Color fundus photograph.
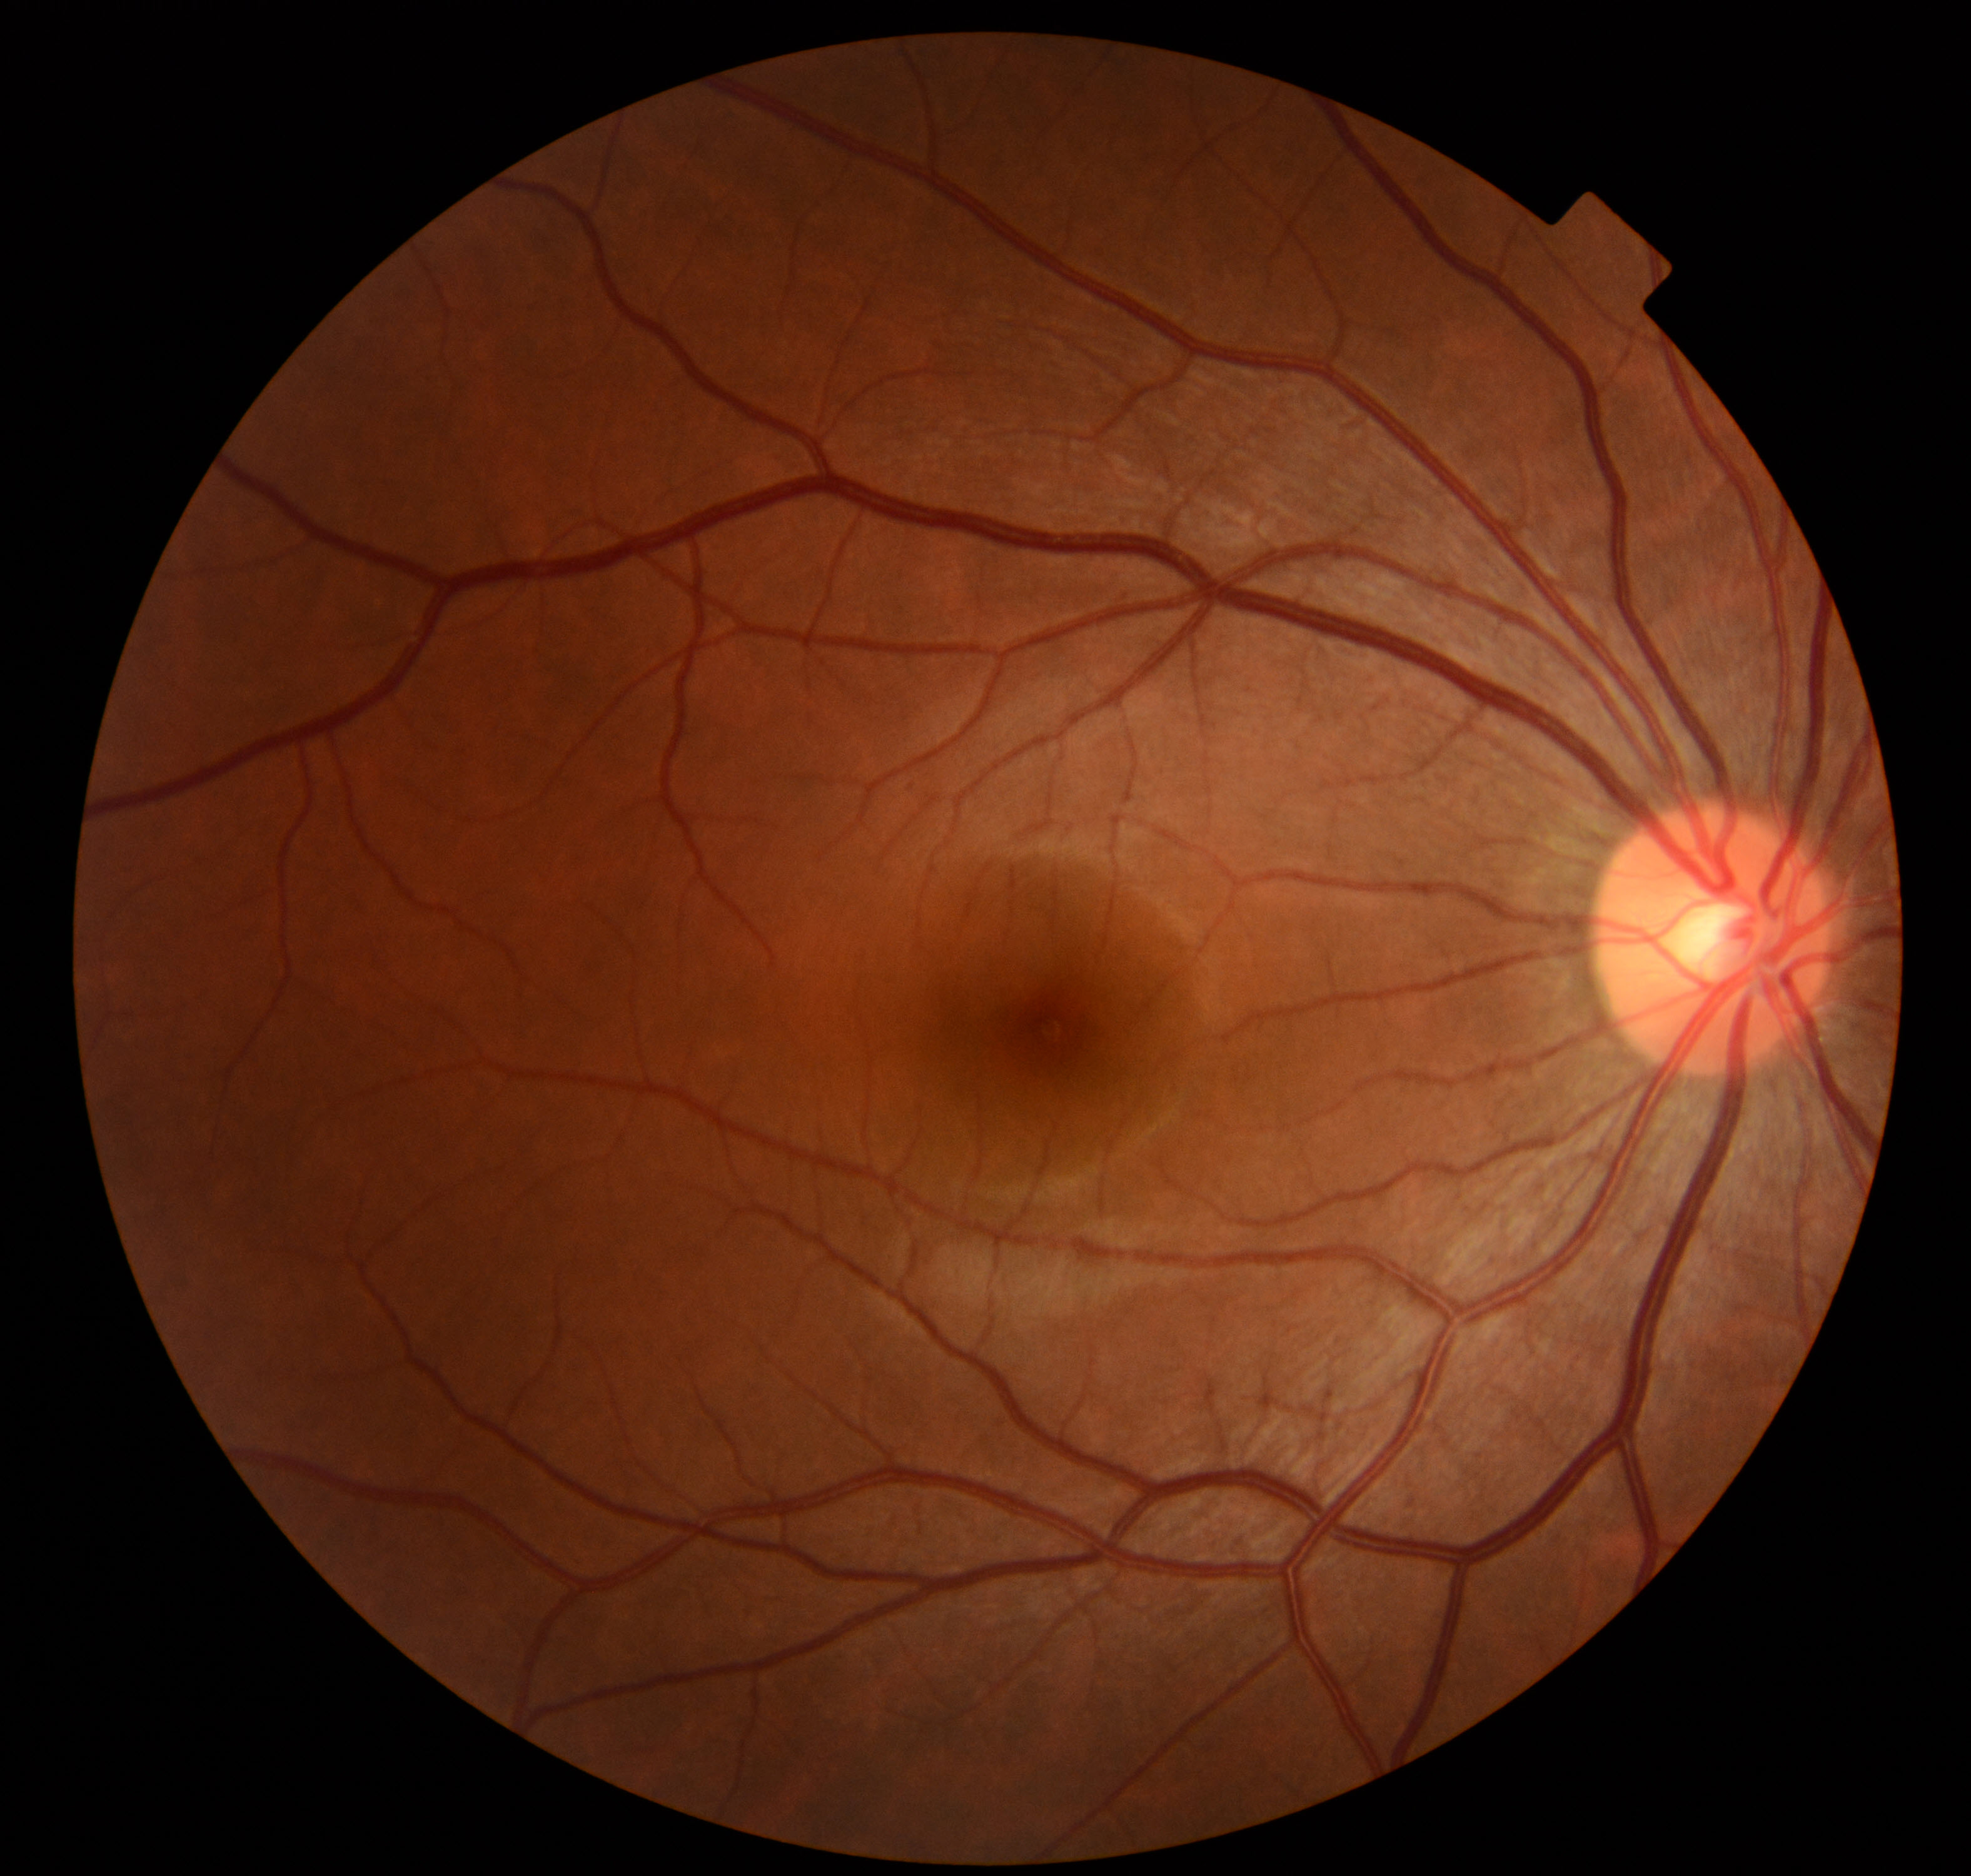
No retinal pathology identified.